Wide-field contact fundus photograph of an infant · 130° field of view (Clarity RetCam 3) — 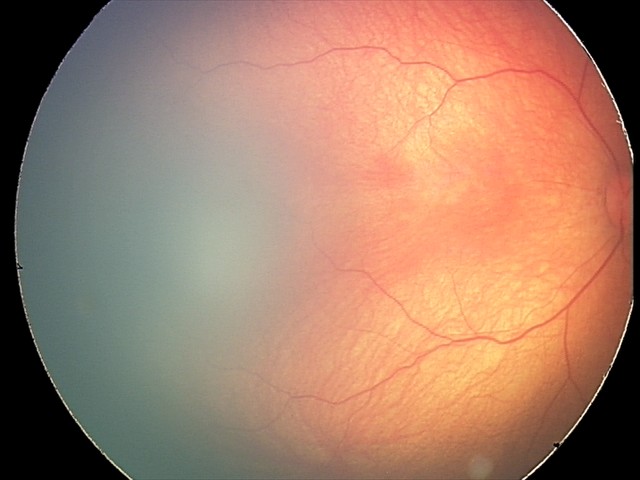 Impression: retinal hemorrhages.